CFP. FOV: 45 degrees. 2212 x 1659 pixels: 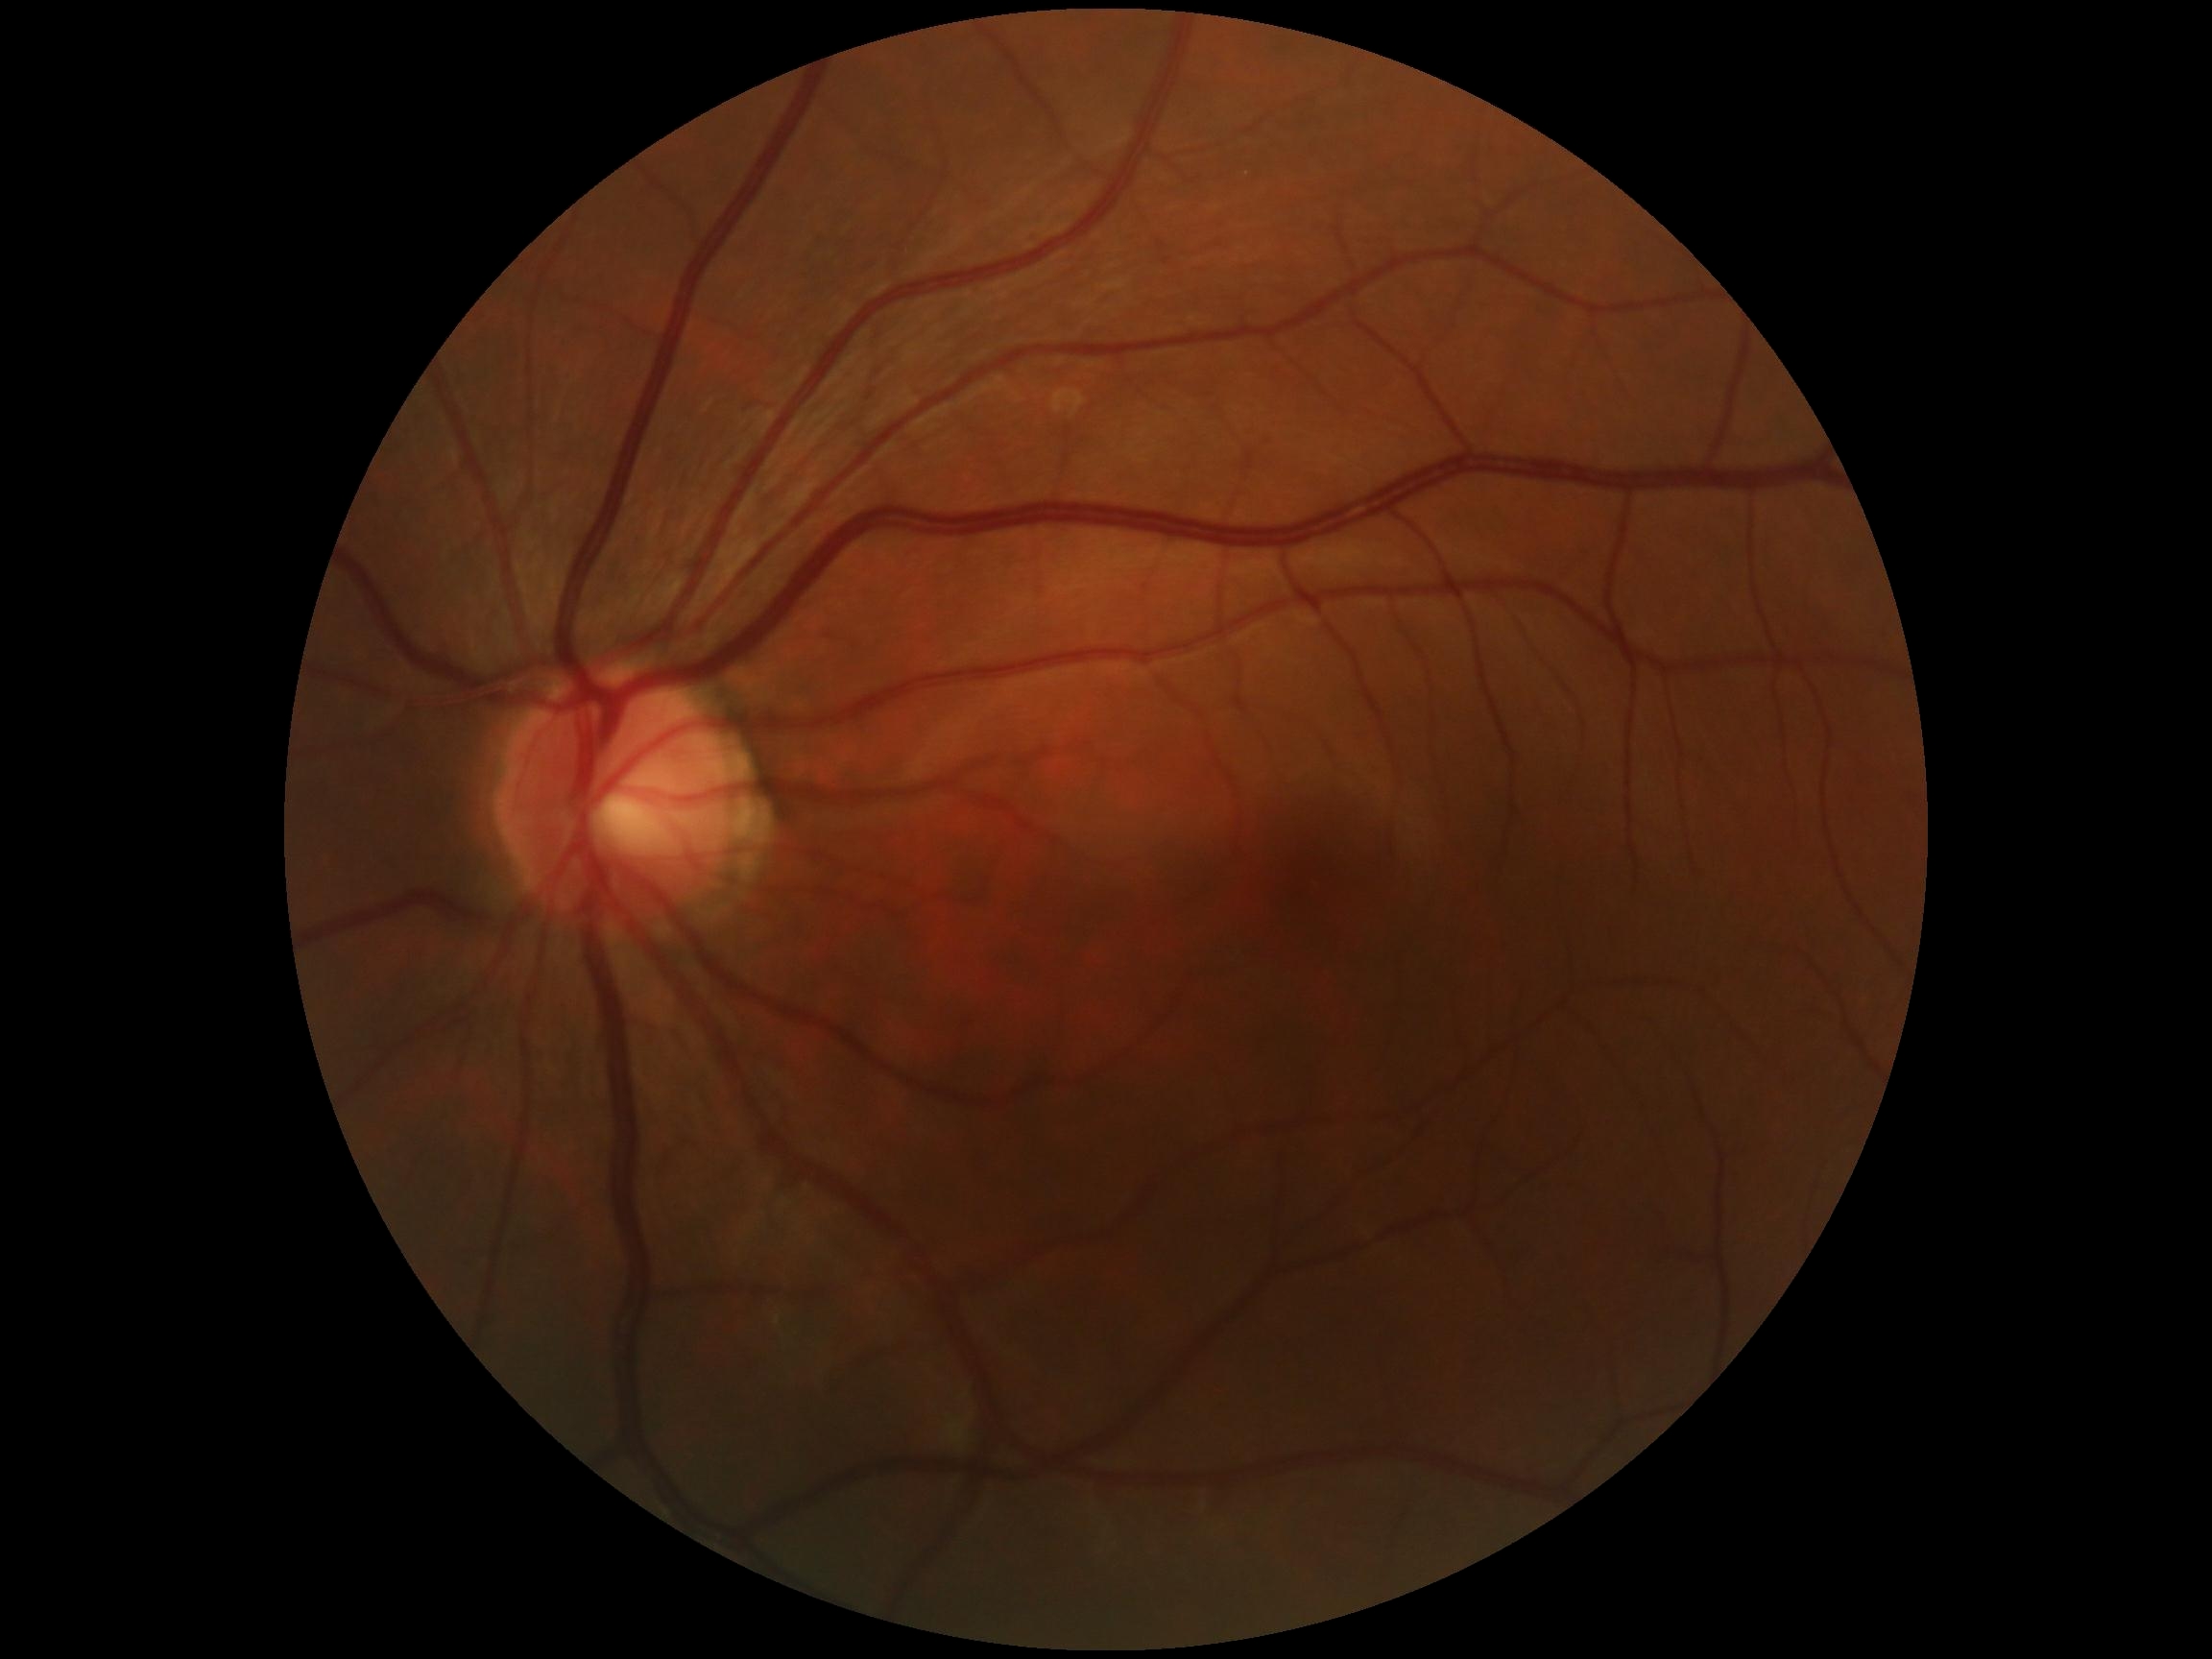
DR severity is 0.